Image size 1240x1240. Camera: Phoenix ICON (100° FOV). Wide-field fundus image from infant ROP screening — 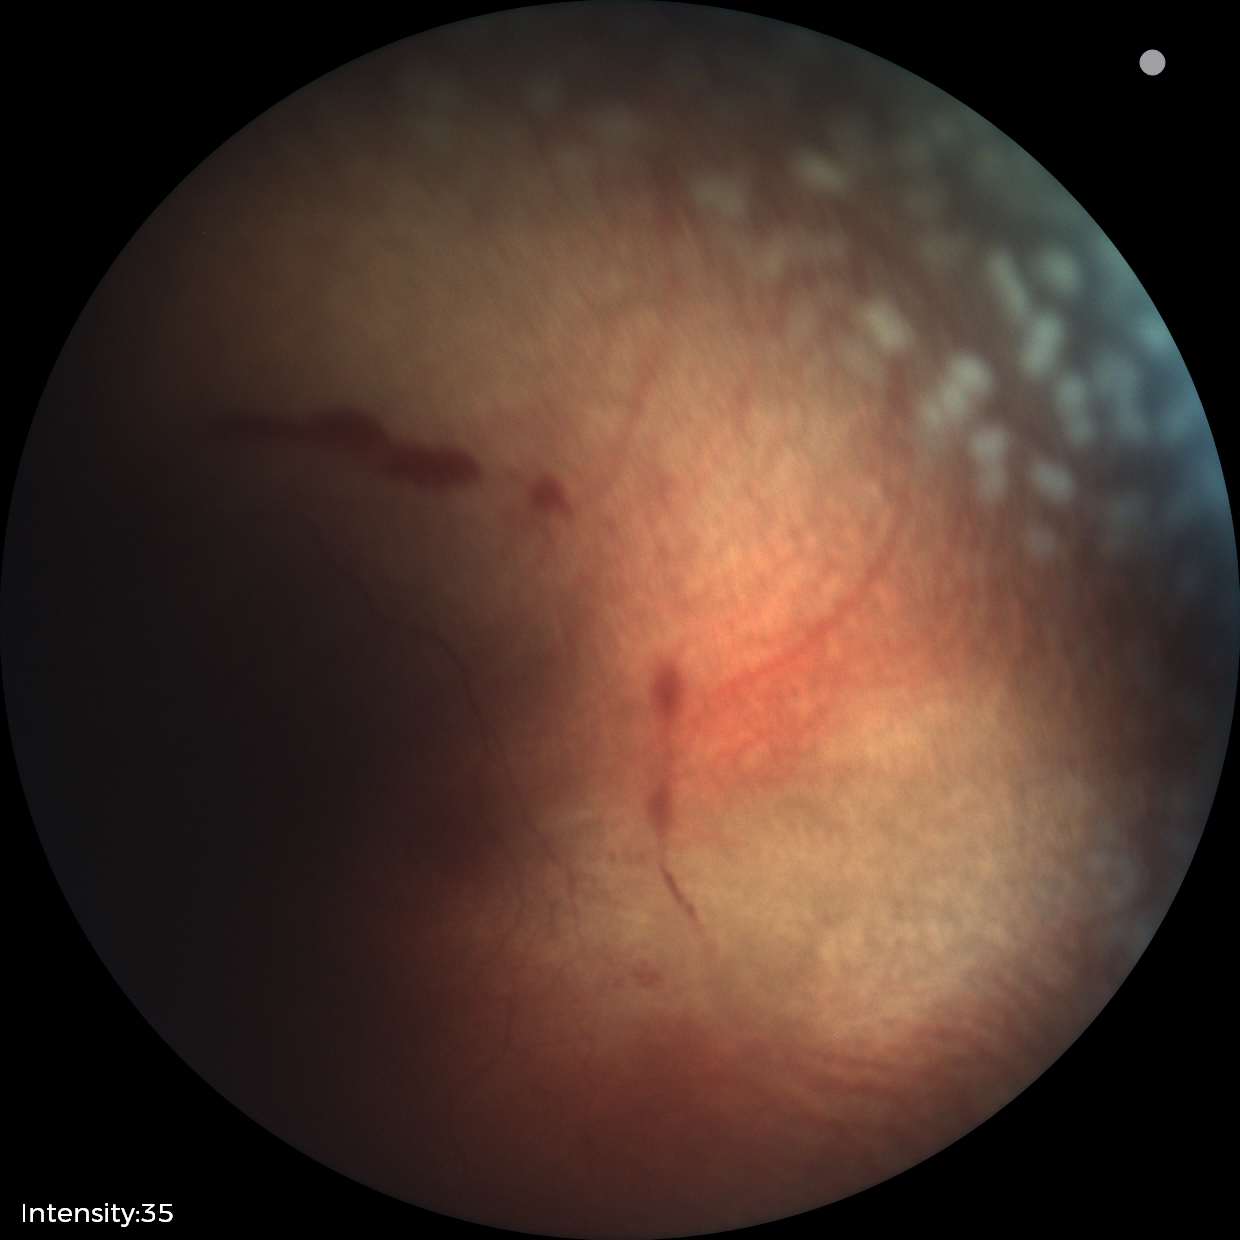 Diagnosis from this screening exam: ROP stage 2. Plus disease was diagnosed.